Diabetic retinopathy graded by the modified Davis classification:
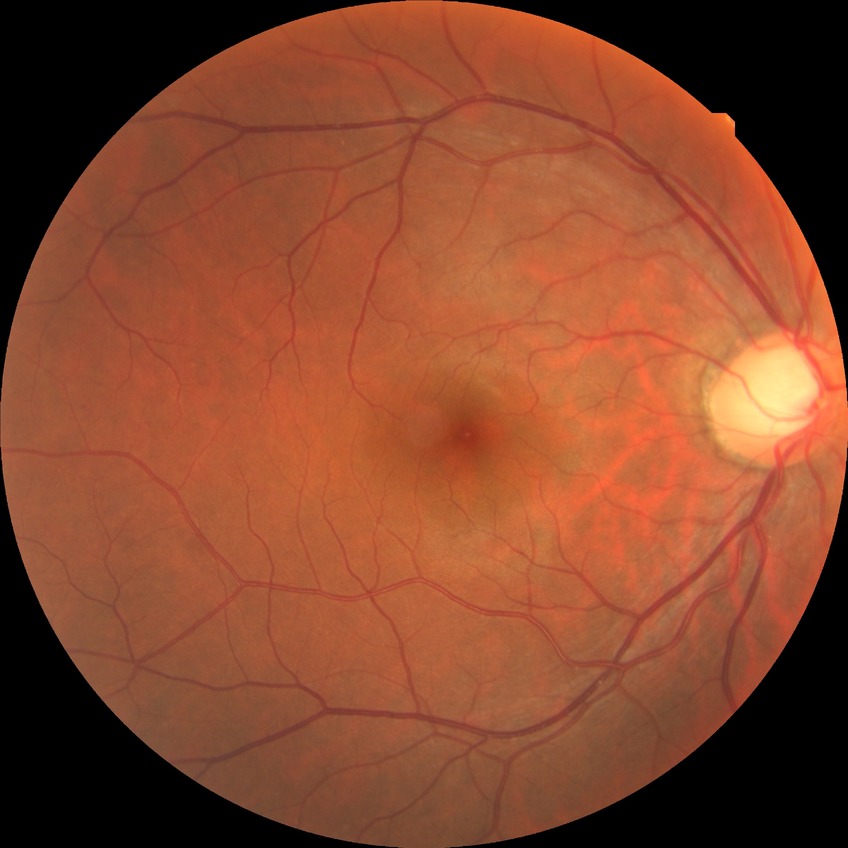
{"davis_grade": "no diabetic retinopathy (NDR)"}